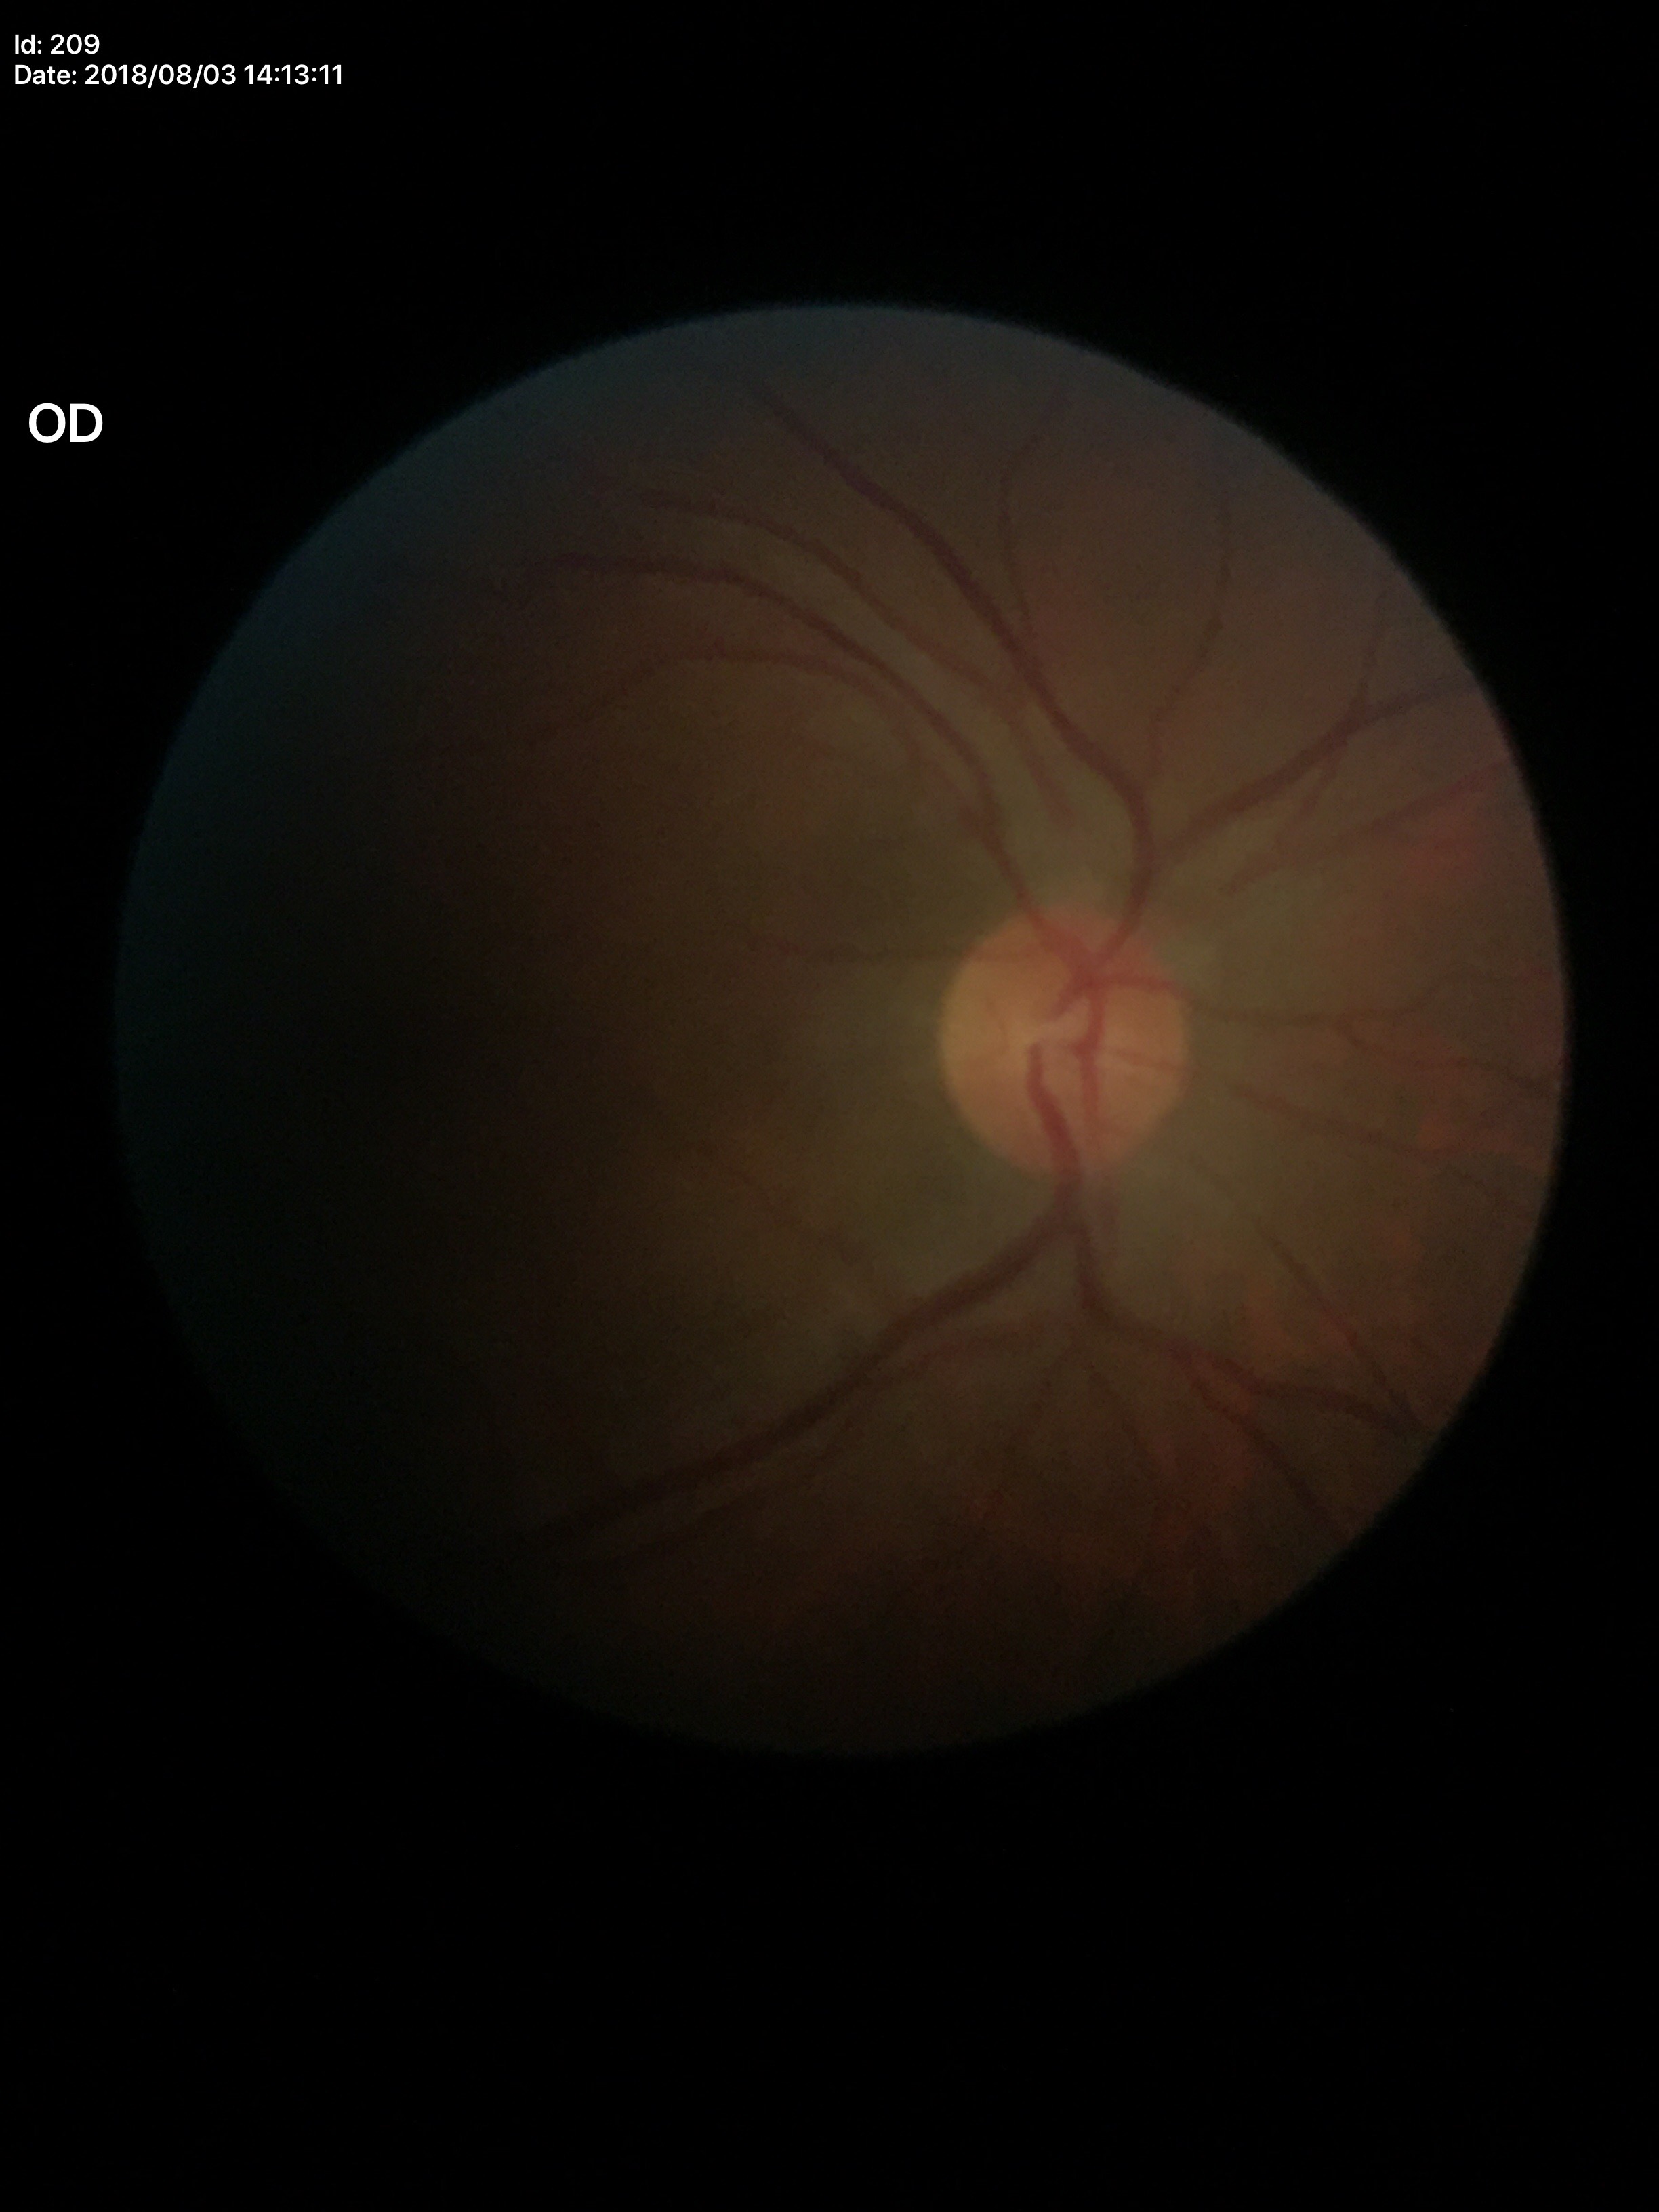

• vertical cup-disc ratio: 0.40
• Glaucoma assessment: negative